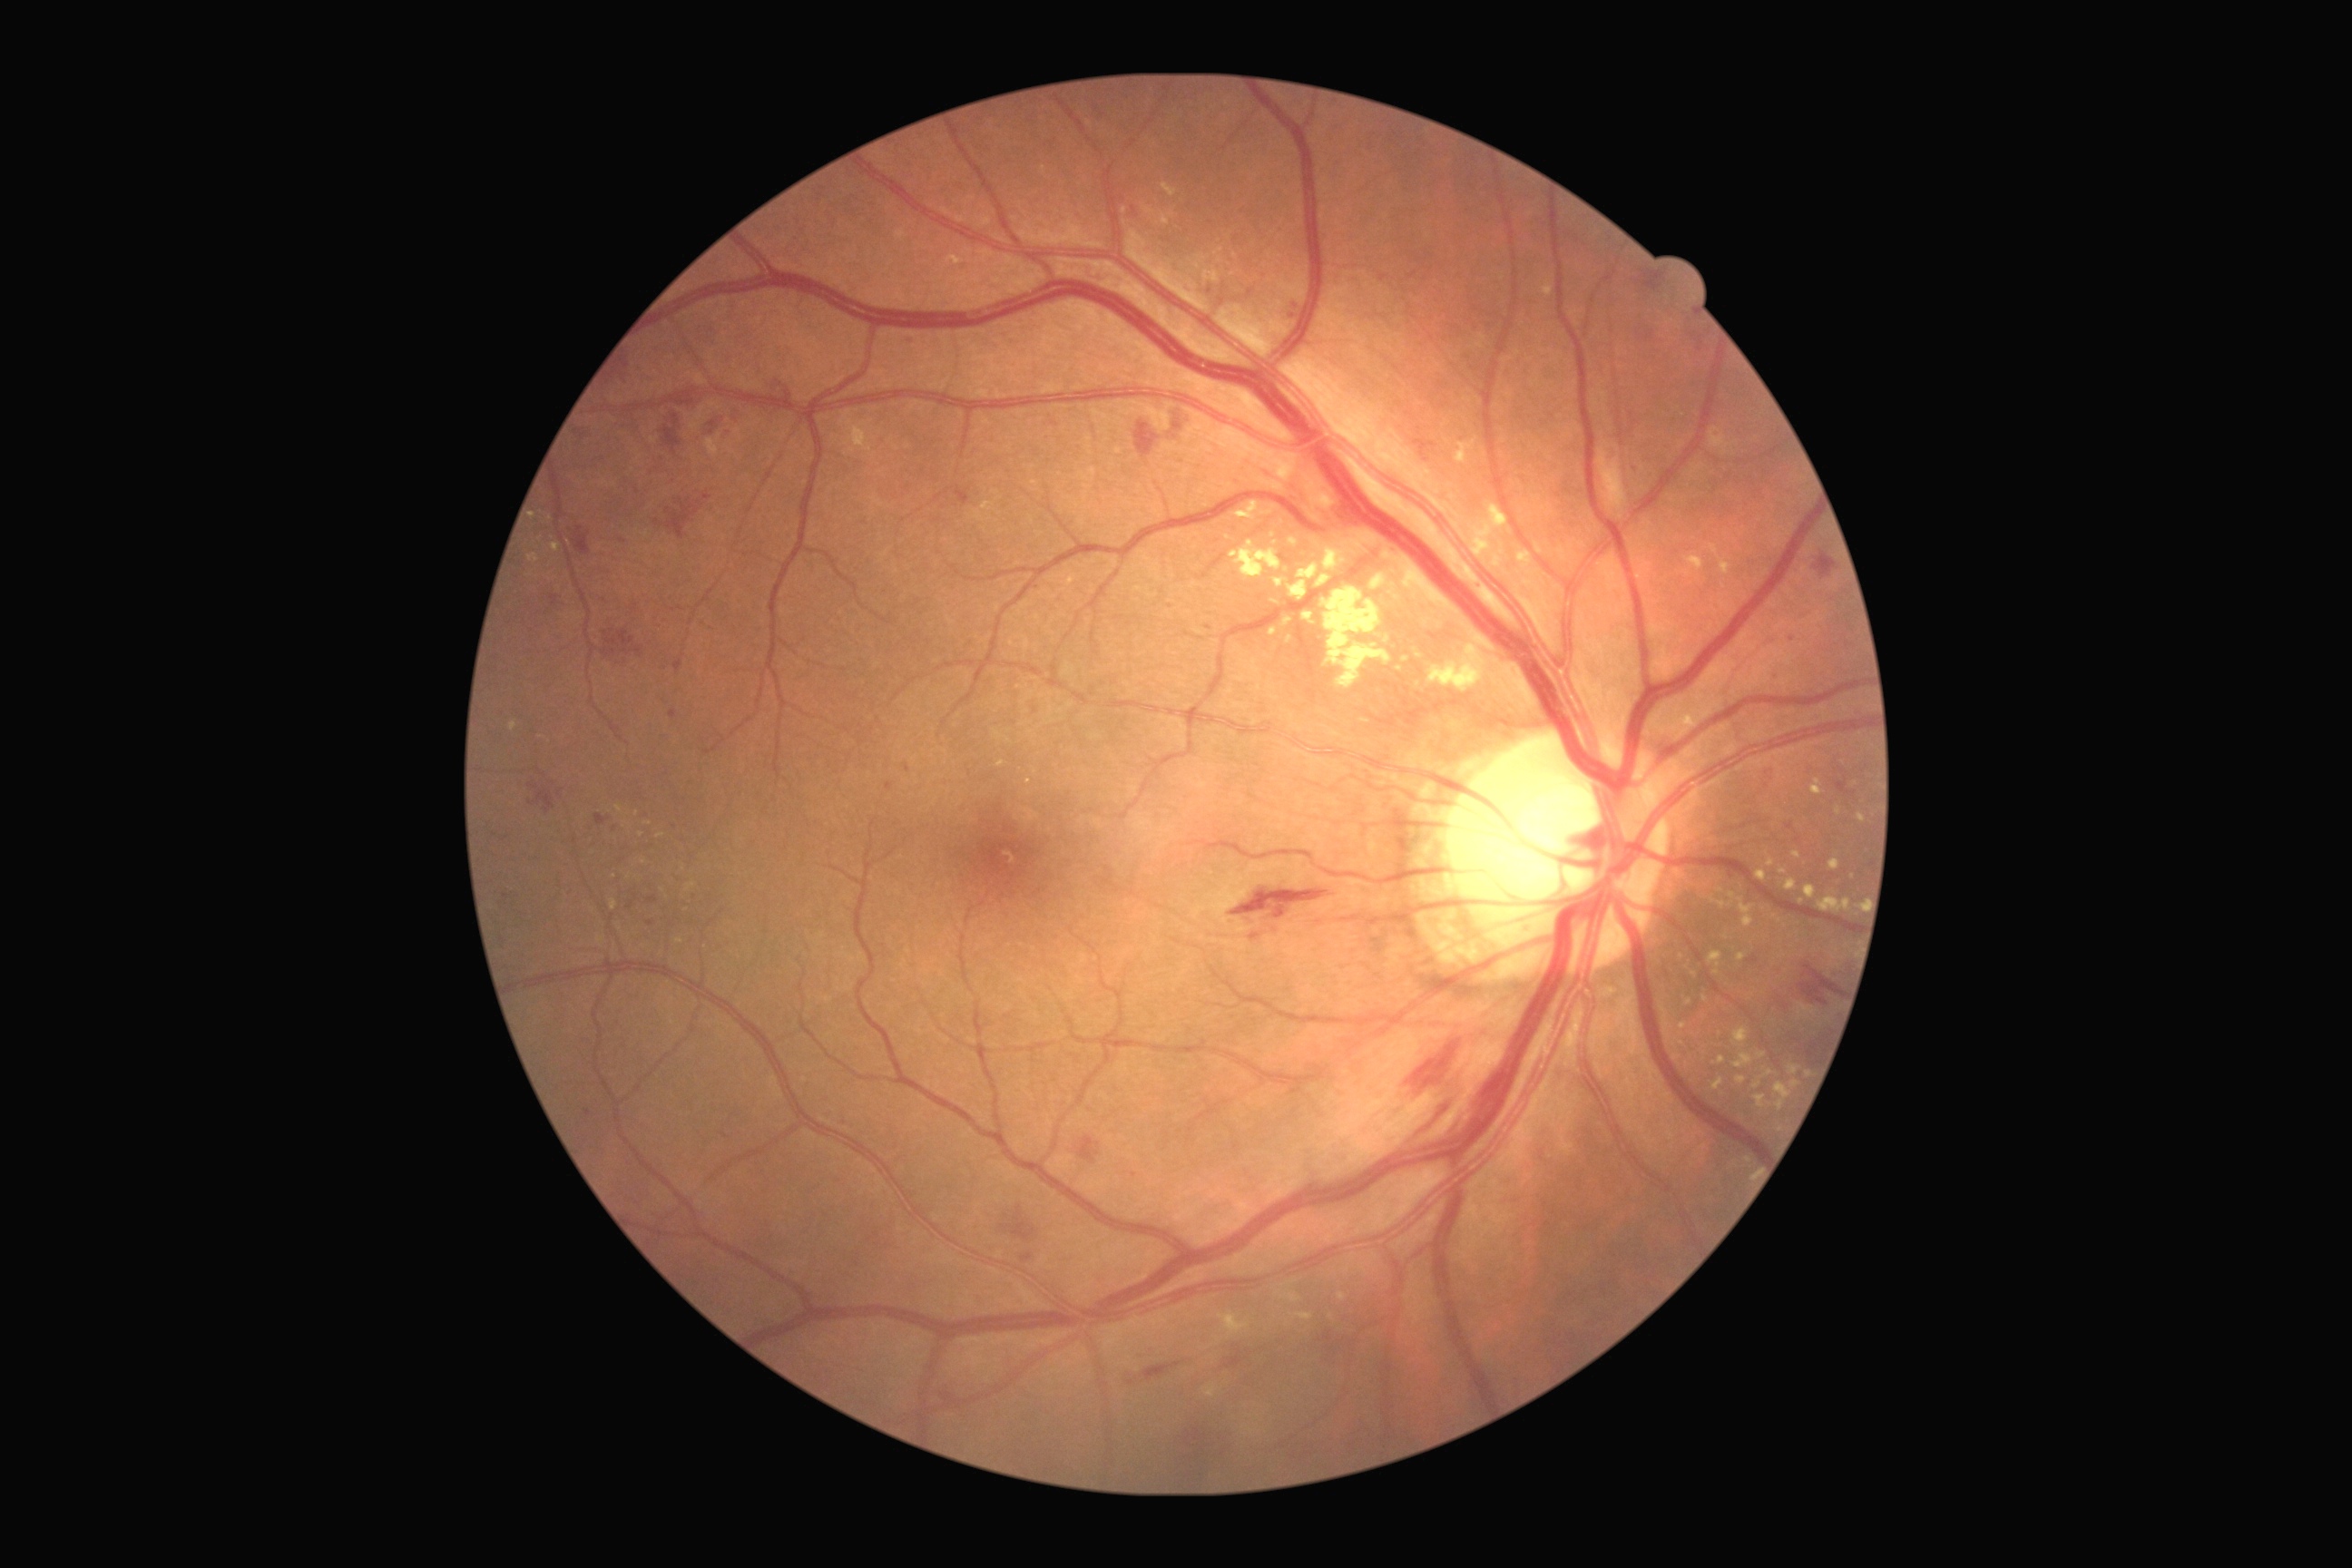 Diabetic retinopathy is grade 2 (moderate NPDR)
Lesions identified (partial list):
hard exudates (subset): rect(1683, 997, 1690, 1008) | rect(1338, 1293, 1346, 1302) | rect(1224, 1311, 1237, 1329) | rect(1282, 618, 1293, 627) | rect(1805, 885, 1818, 899) | rect(1297, 564, 1320, 580) | rect(611, 899, 618, 912) | rect(1776, 1083, 1792, 1110) | rect(1857, 903, 1865, 910) | rect(1415, 649, 1424, 658) | rect(598, 937, 605, 945) | rect(1785, 879, 1798, 890) | rect(1709, 544, 1732, 576) | rect(1712, 1079, 1725, 1092)
Smaller hard exudates around point(1331, 1317) | point(638, 814) | point(1406, 659) | point(1125, 210)